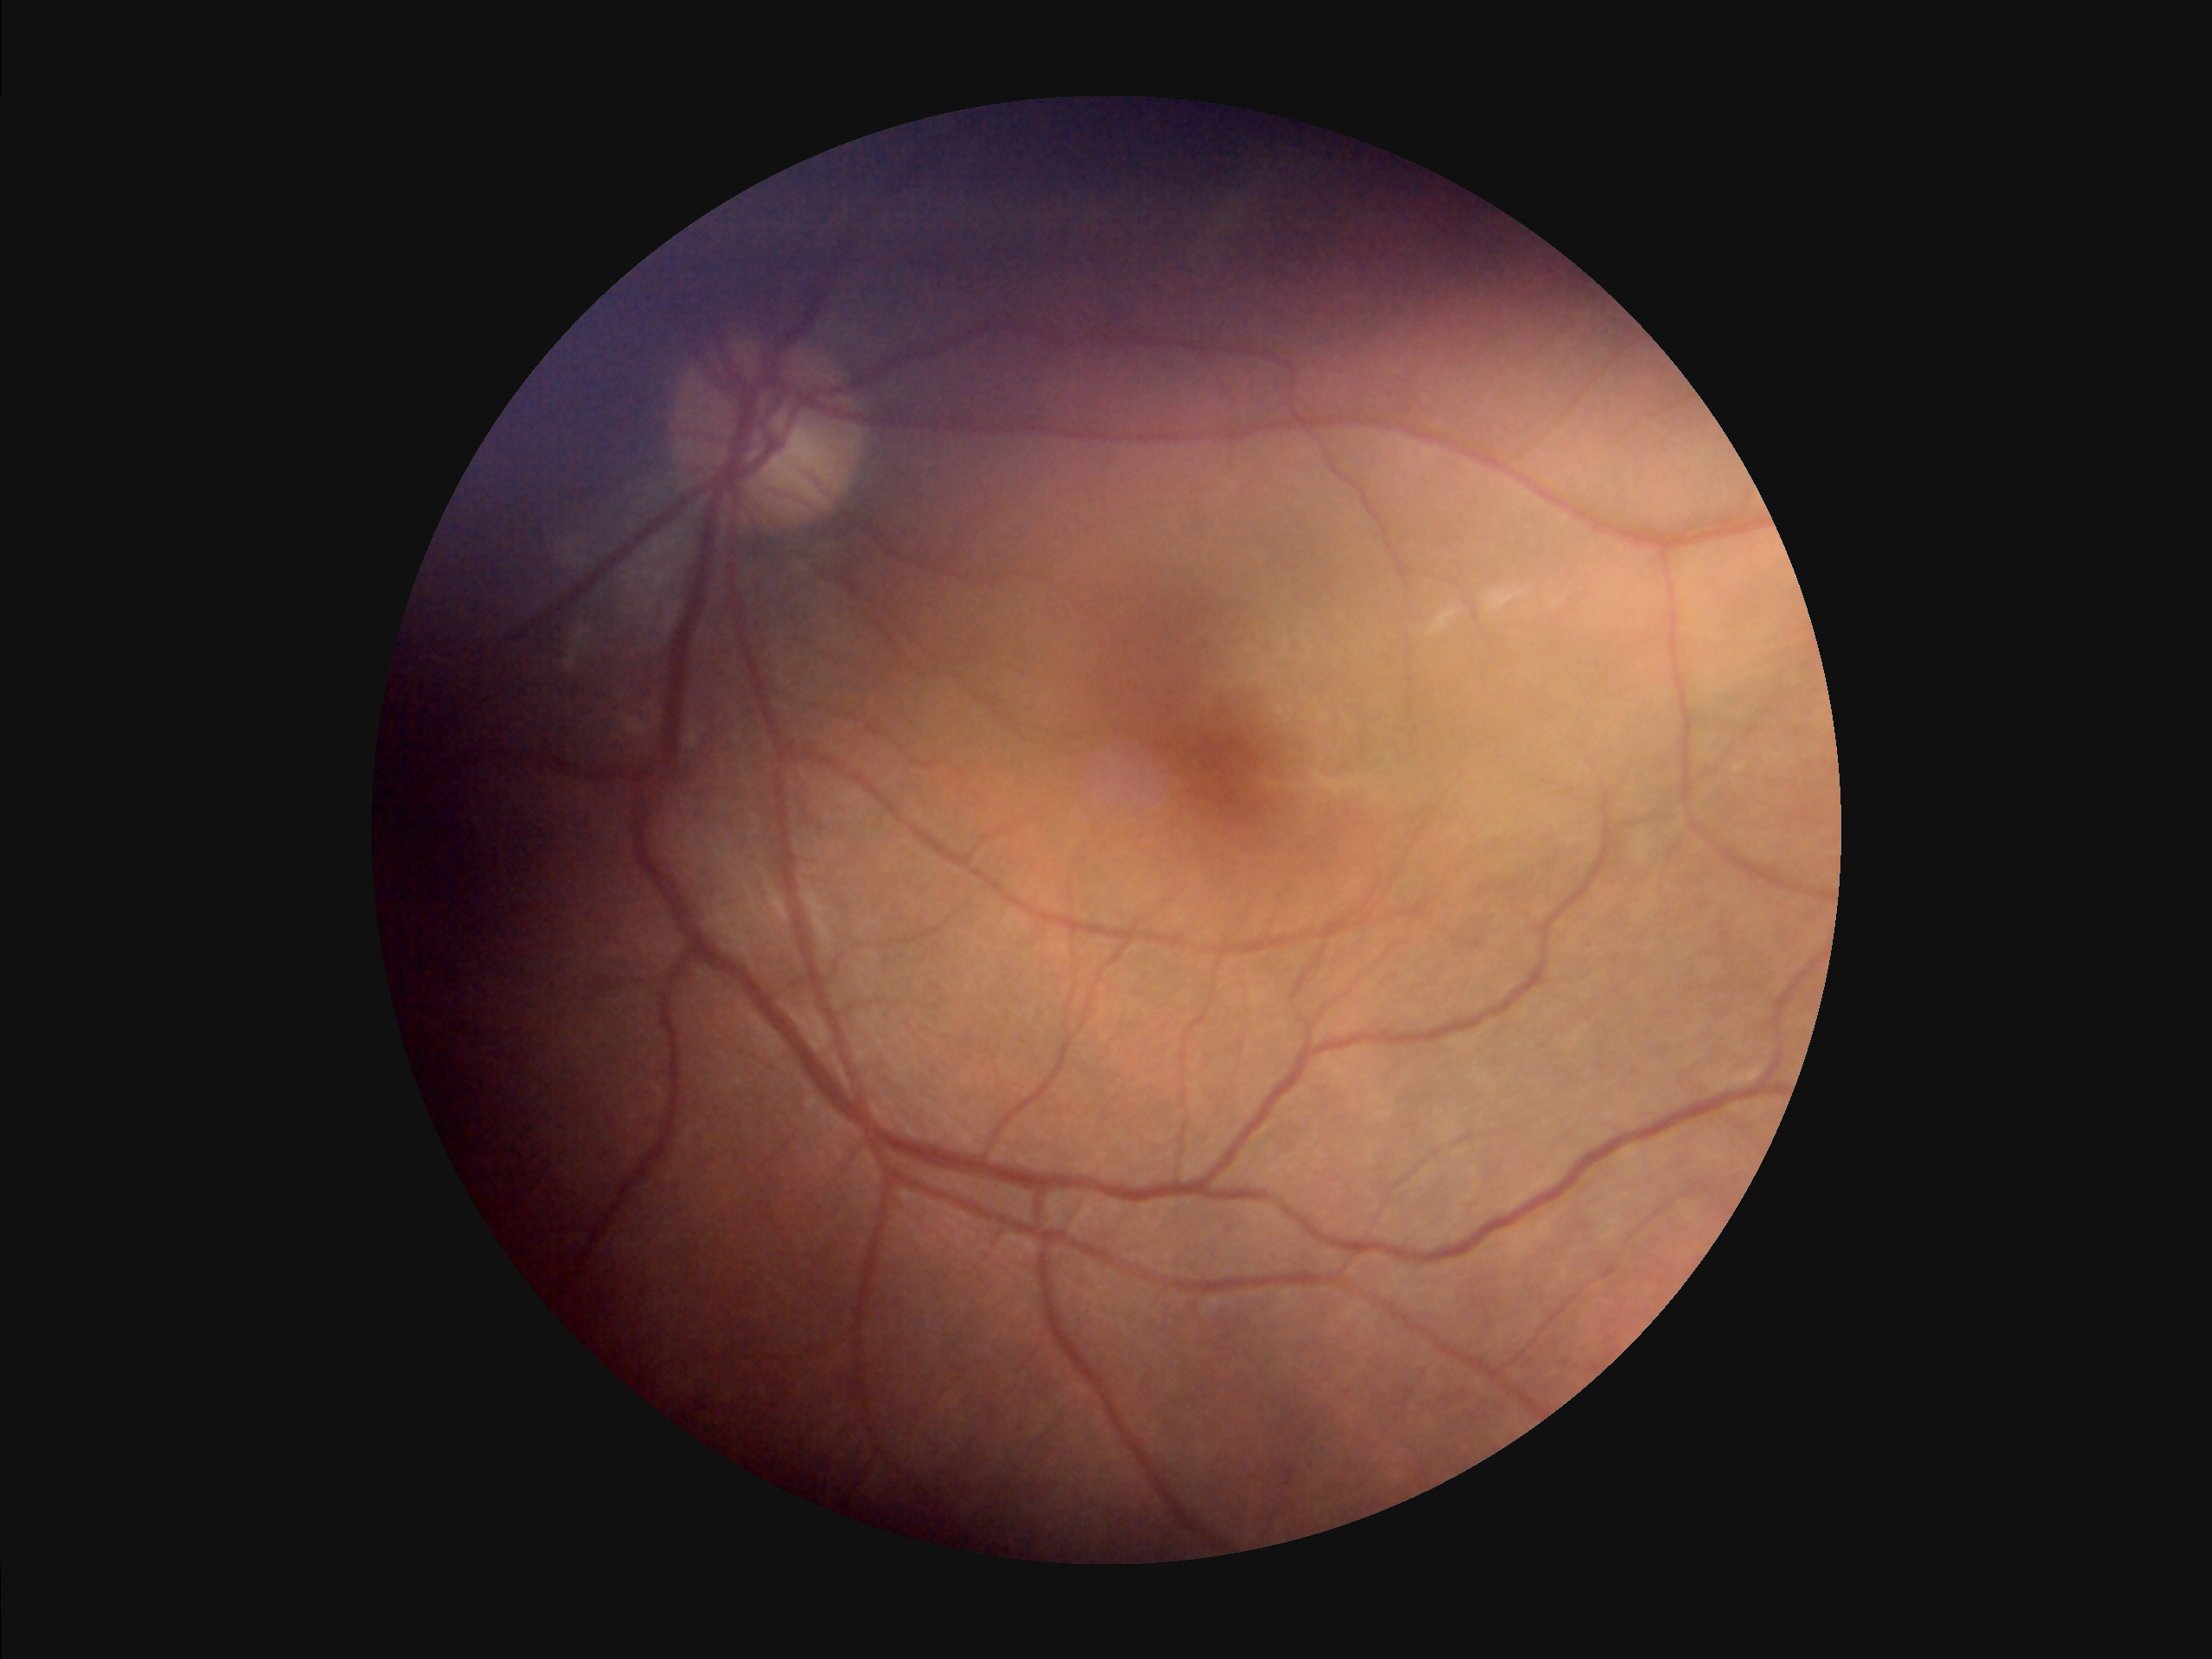
Out of focus; structures are indistinct. Illumination and color are suboptimal. Overall image quality is poor.